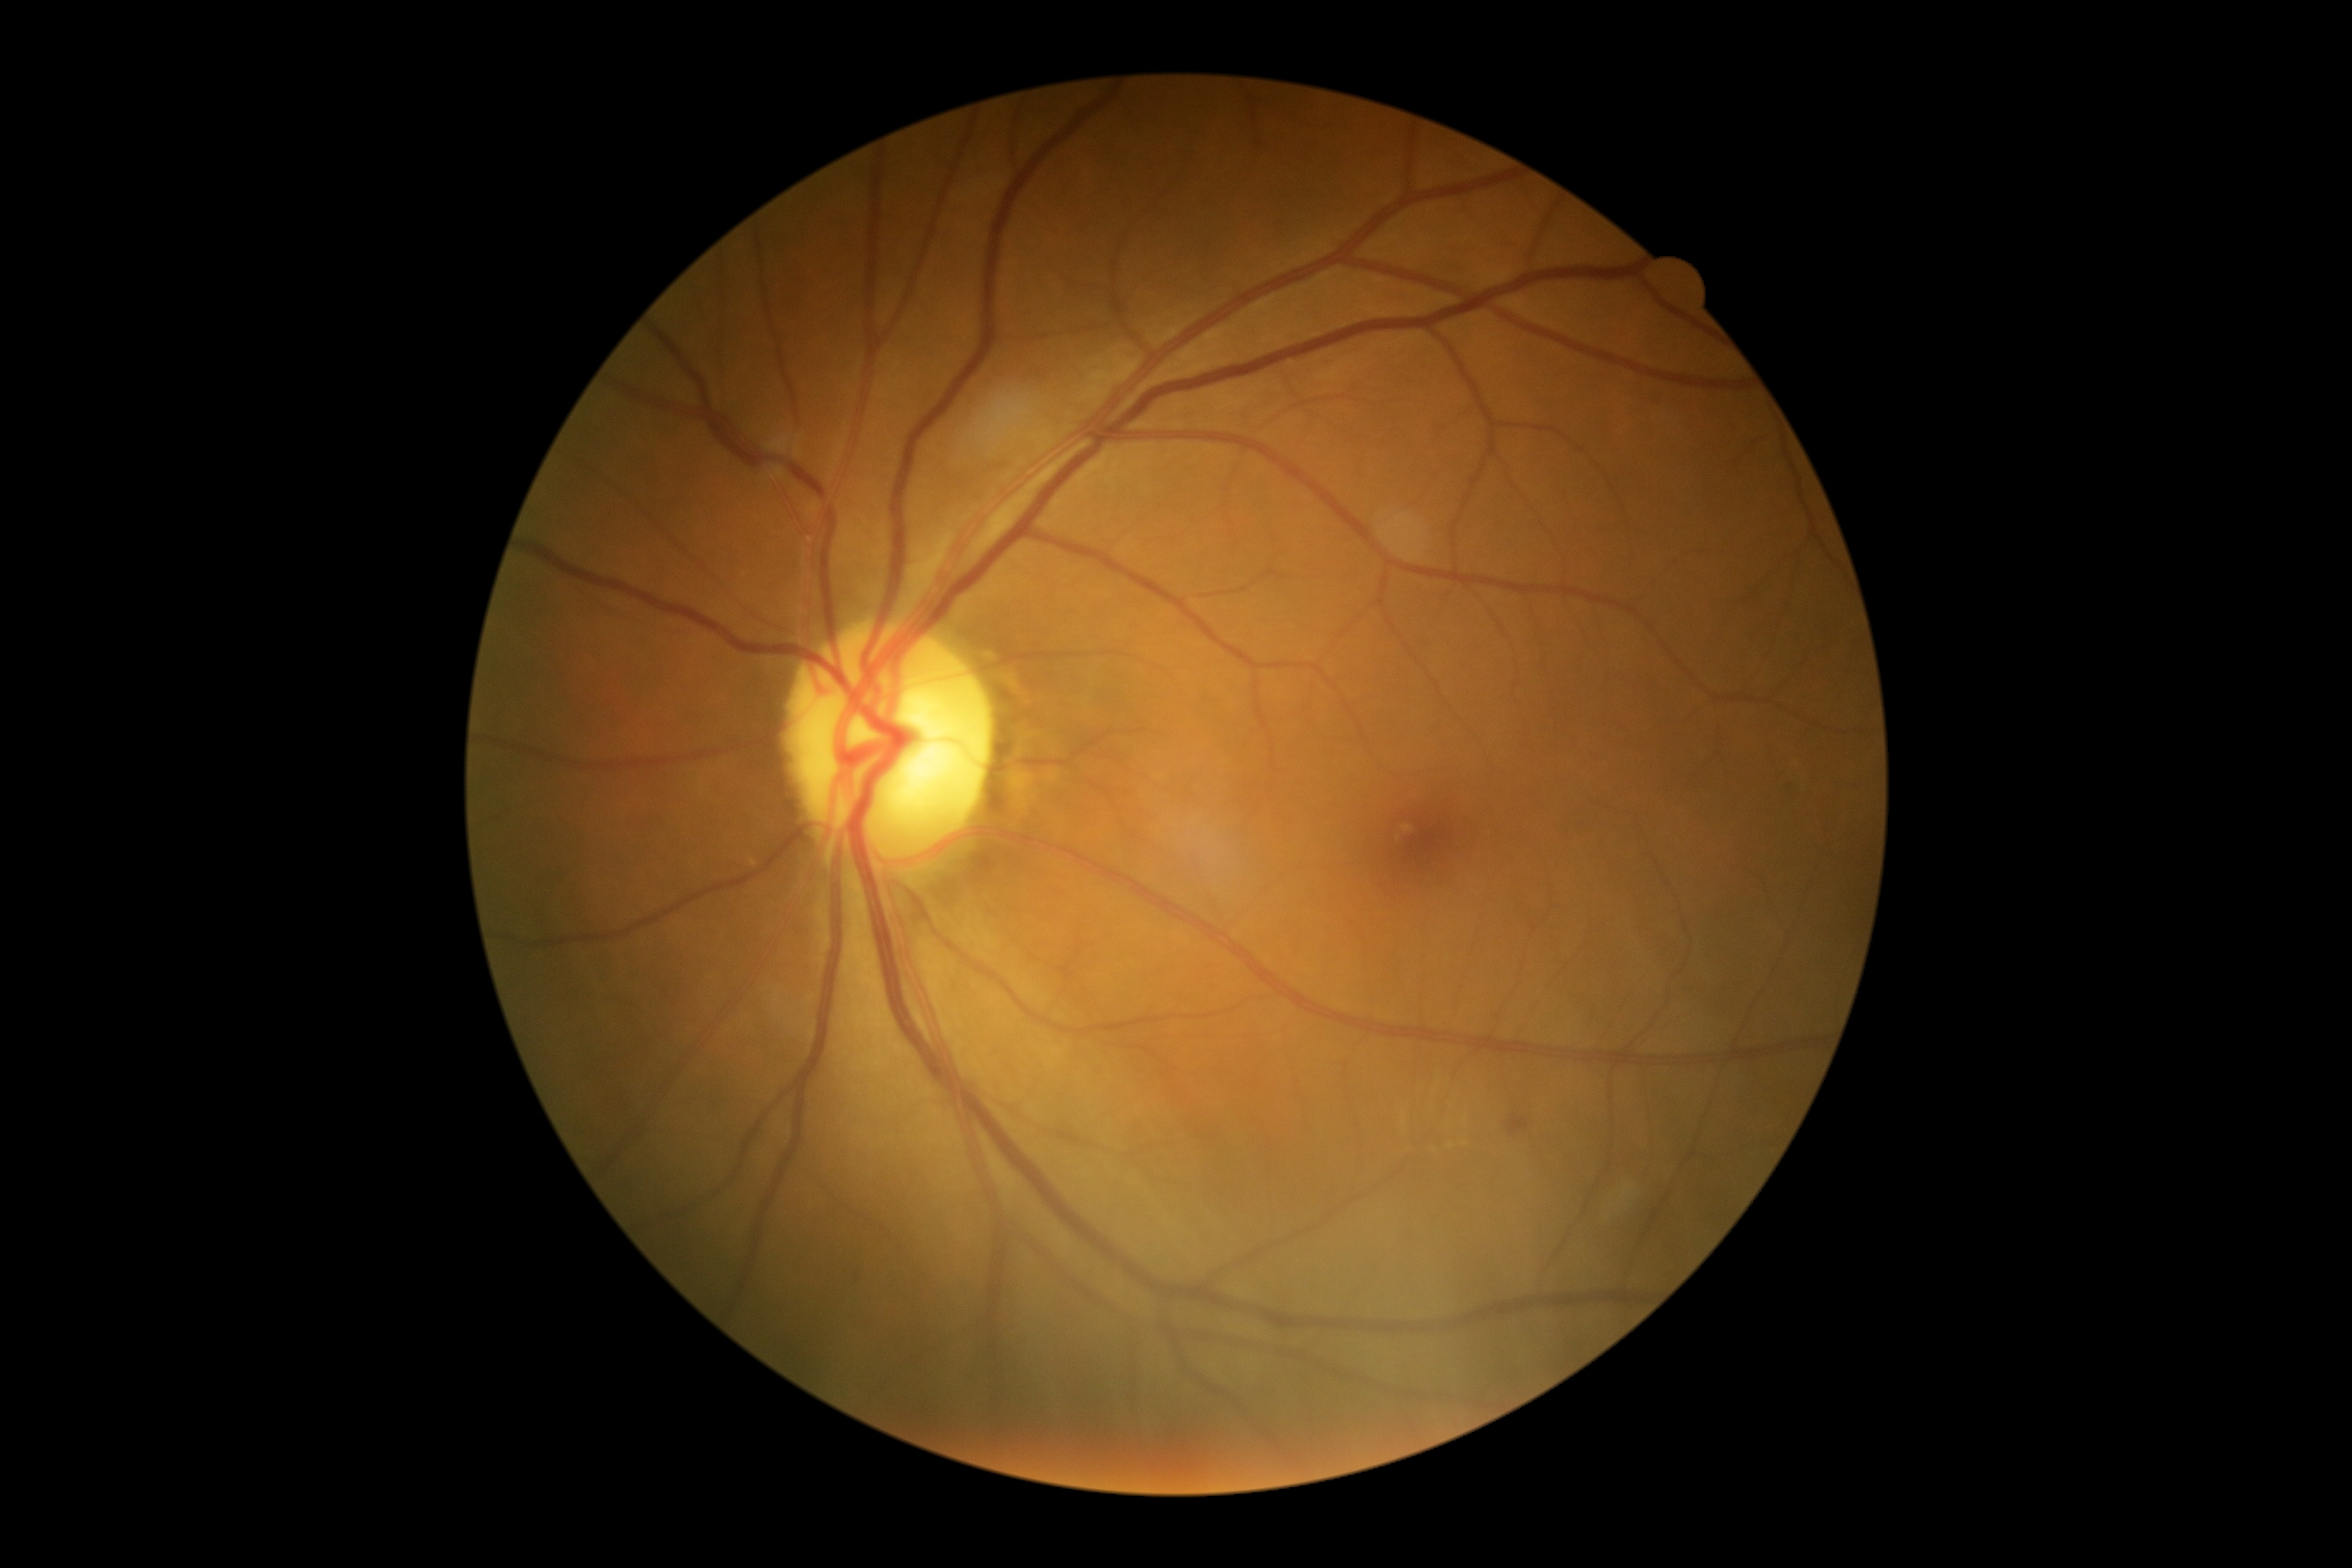

DR class: non-proliferative diabetic retinopathy.
Retinopathy: moderate non-proliferative diabetic retinopathy (grade 2) — more than just microaneurysms but less than severe NPDR.